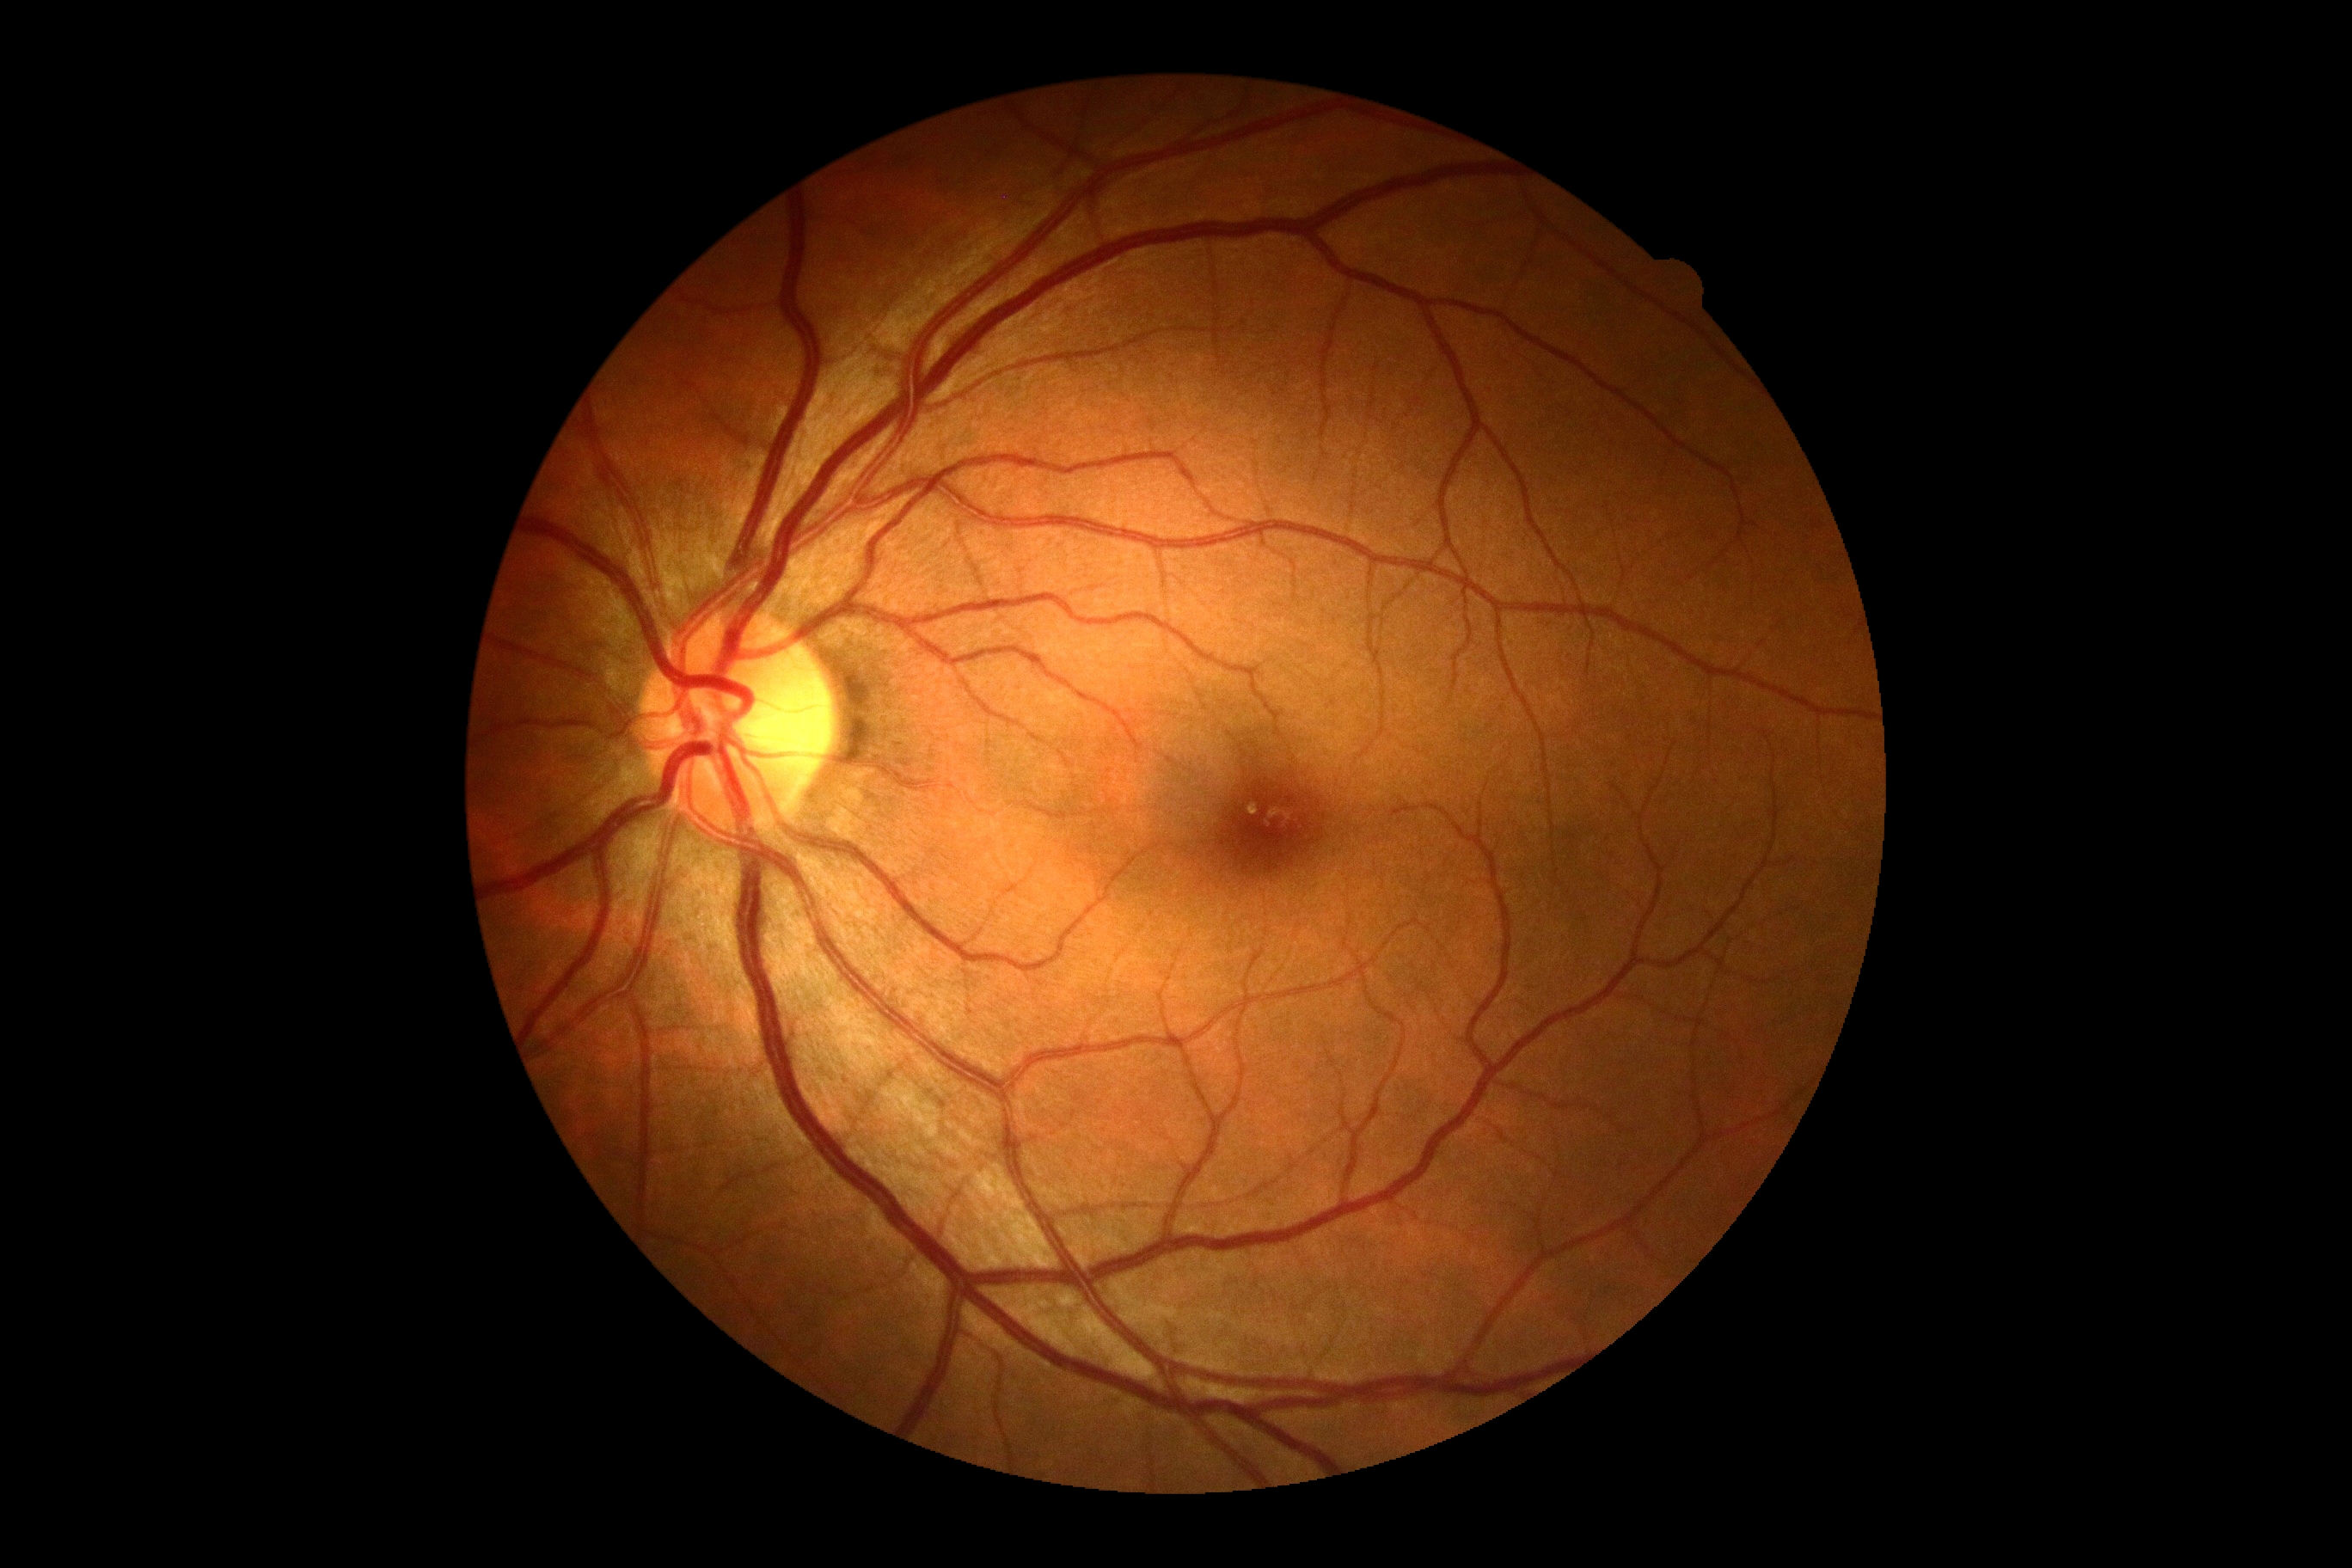

DR grade is 0.